Acquired with a NIDEK AFC-230; retinal fundus photograph; 848x848; 45-degree field of view
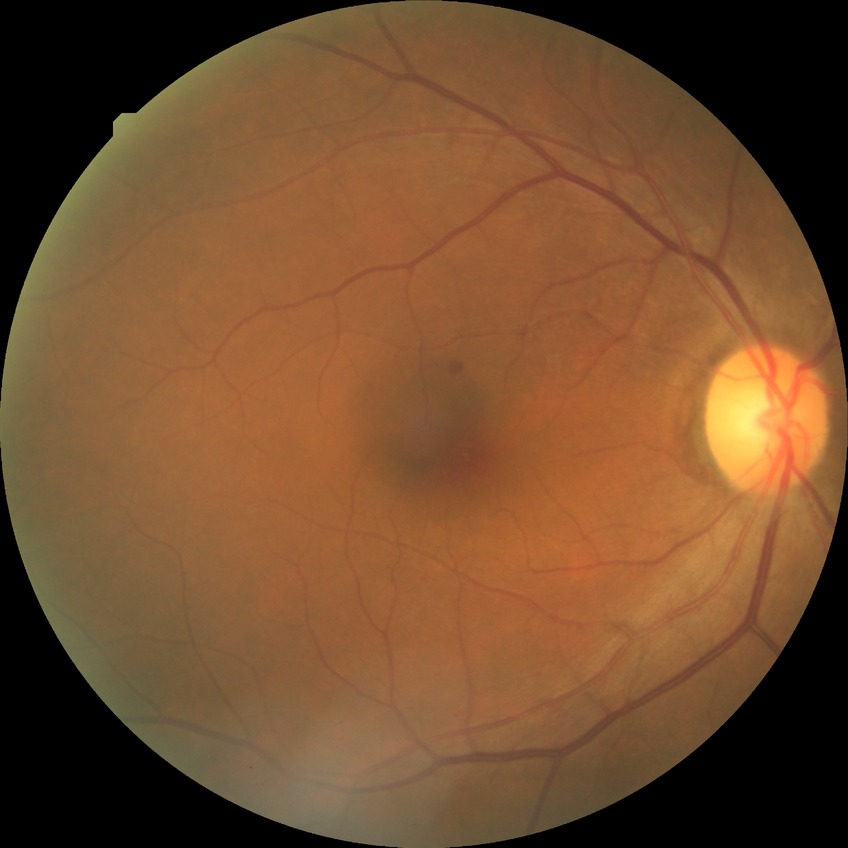
  davis_grade: simple diabetic retinopathy